Retinal fundus photograph, NIDEK AFC-230 — 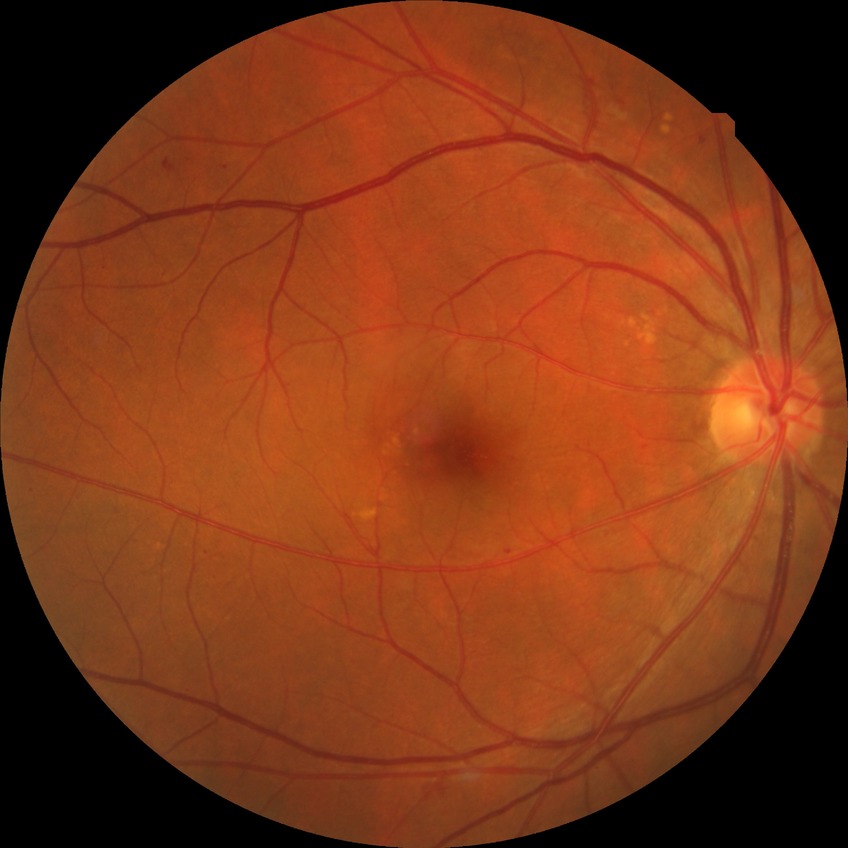   davis_grade: SDR